Nonmydriatic fundus photograph, CFP:
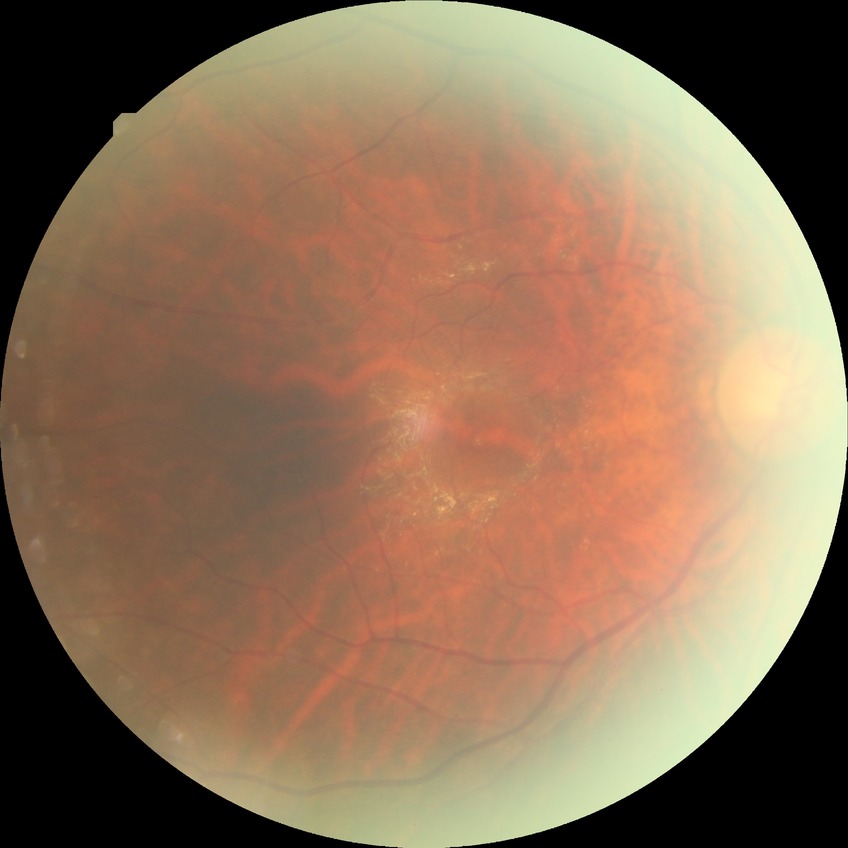

davis_grade: simple diabetic retinopathy